Retinal fundus photograph, 2212x1659px, 45° field of view — 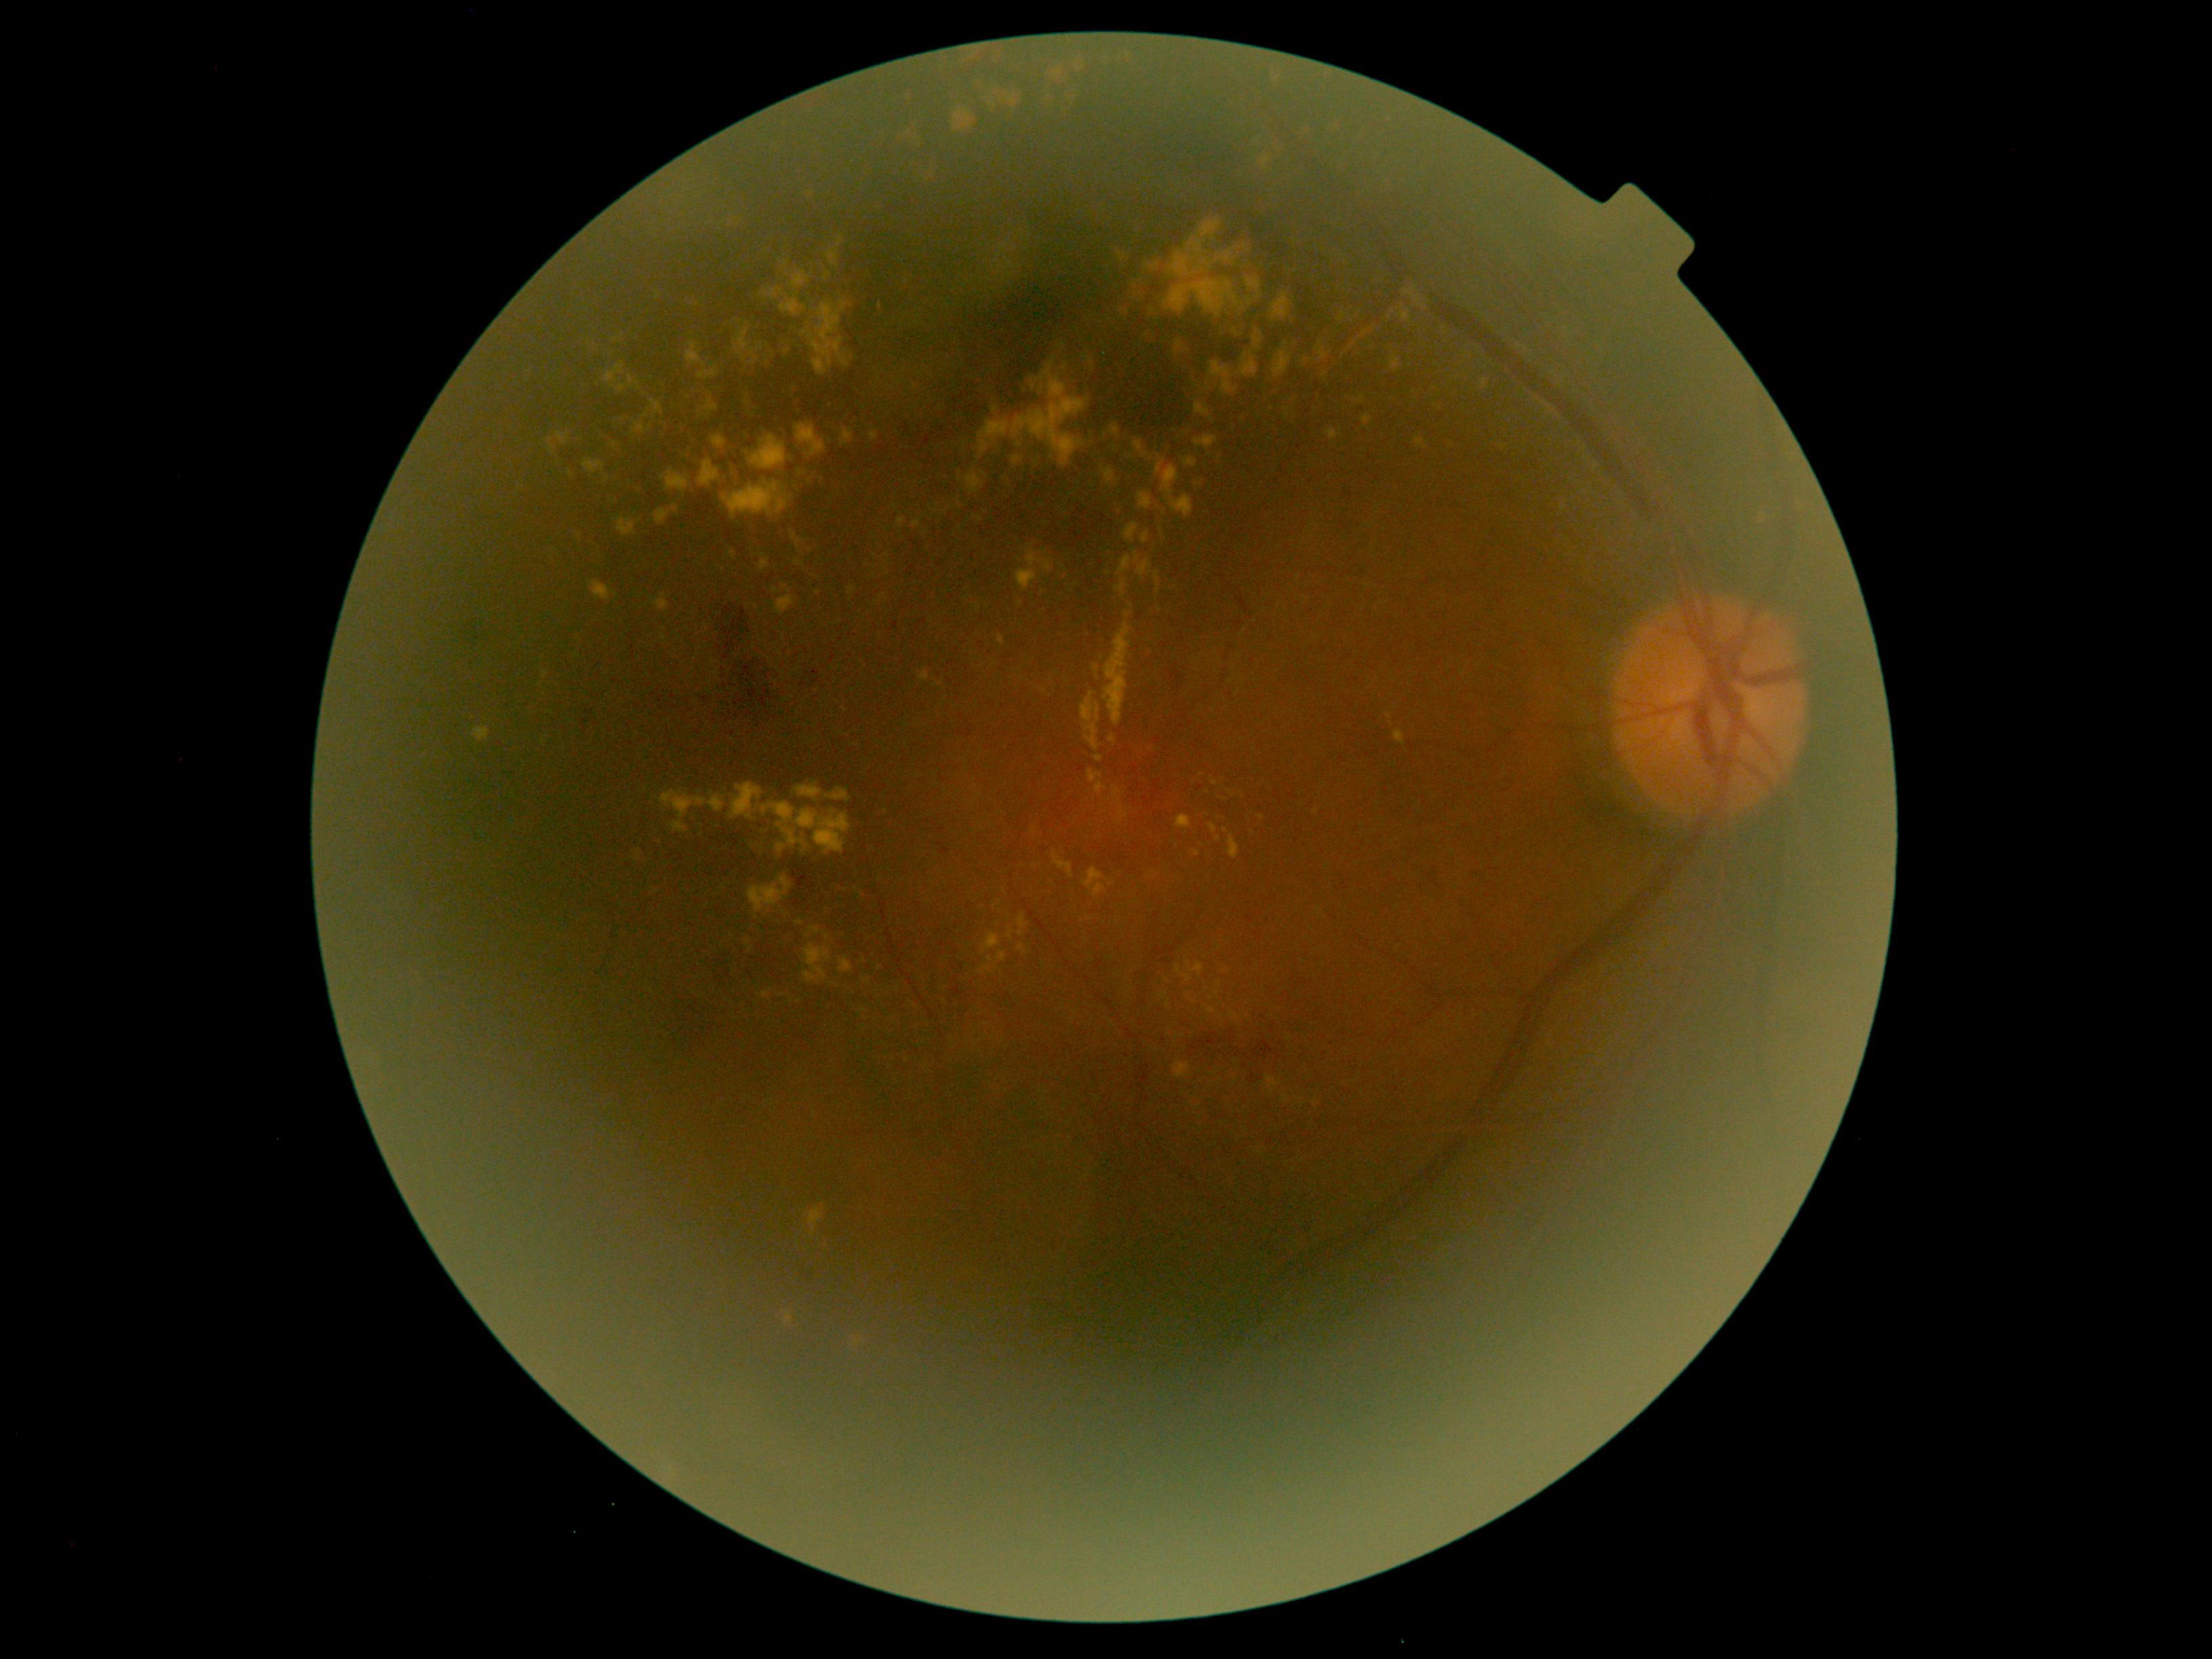
{"partial": true, "dr_grade": 2, "lesions": {"ex": [[1176, 815, 1192, 830], [1108, 735, 1116, 743], [1165, 279, 1245, 319], [819, 1235, 832, 1252], [1134, 438, 1154, 459], [758, 559, 769, 571], [790, 272, 810, 288], [1254, 338, 1263, 349], [921, 669, 929, 682], [768, 288, 807, 316], [1181, 960, 1204, 983]], "ex_small_approx": [[544, 741], [1112, 883], [1212, 419], [1220, 1018], [1326, 375], [545, 675], [1316, 813], [958, 507], [654, 890]]}}